Davis DR grading. Camera: NIDEK AFC-230. 45° field of view:
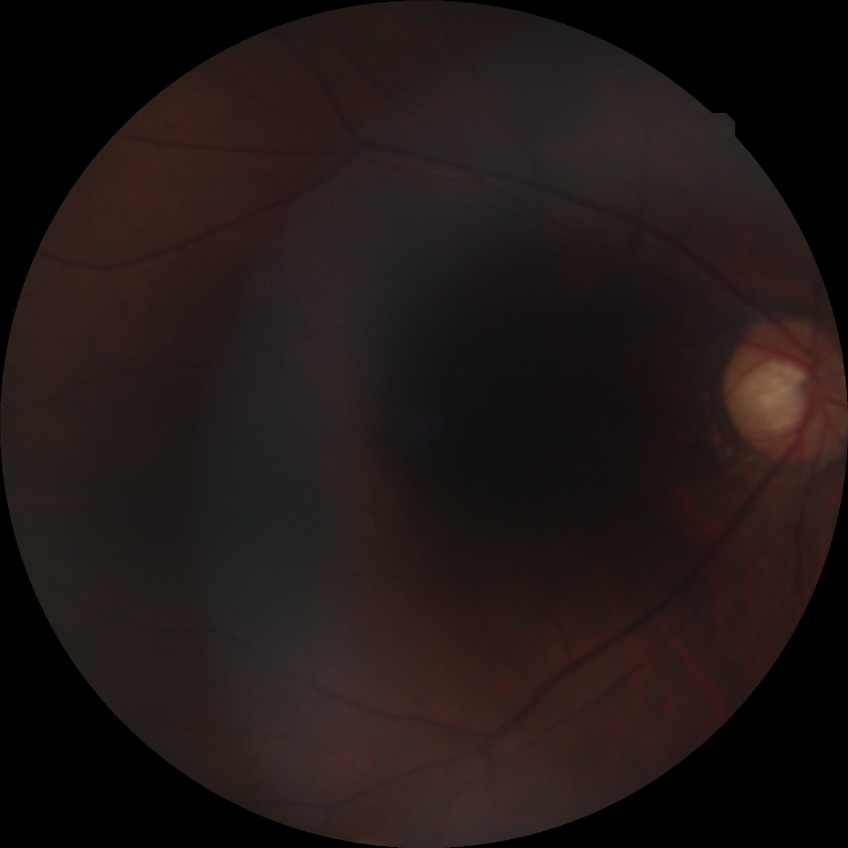 Modified Davis classification is no diabetic retinopathy.